Diabetic retinopathy graded by the modified Davis classification. Acquired with a NIDEK AFC-230. Nonmydriatic fundus photograph
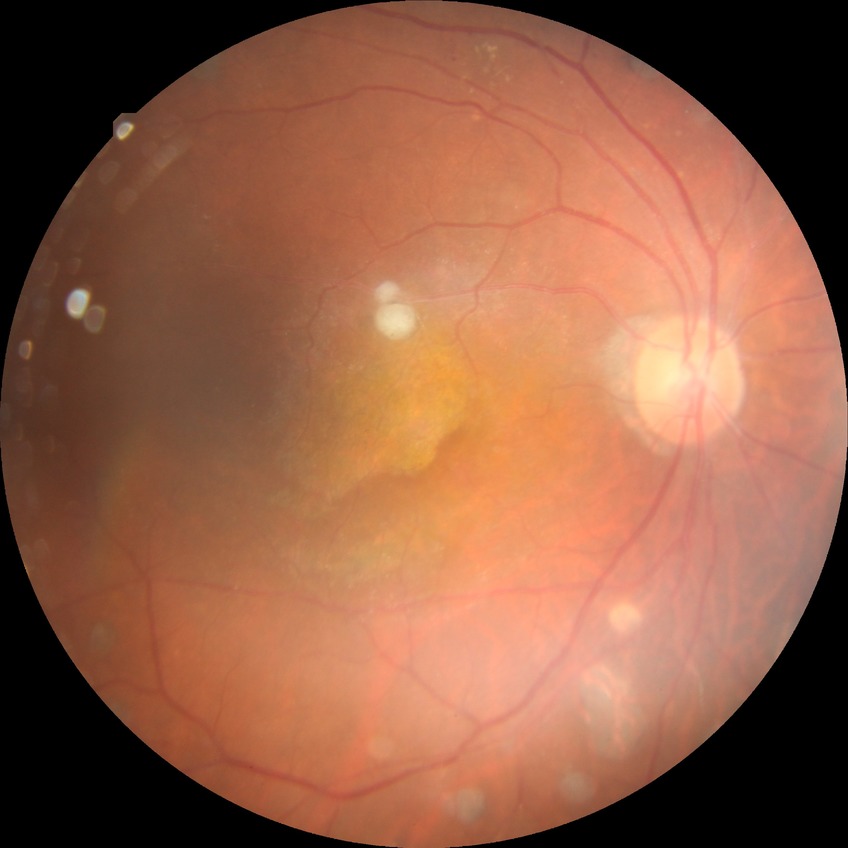 Diabetic retinopathy (DR) is proliferative diabetic retinopathy (PDR).